FOV: 45 degrees, image size 2352x1568, retinal fundus photograph.
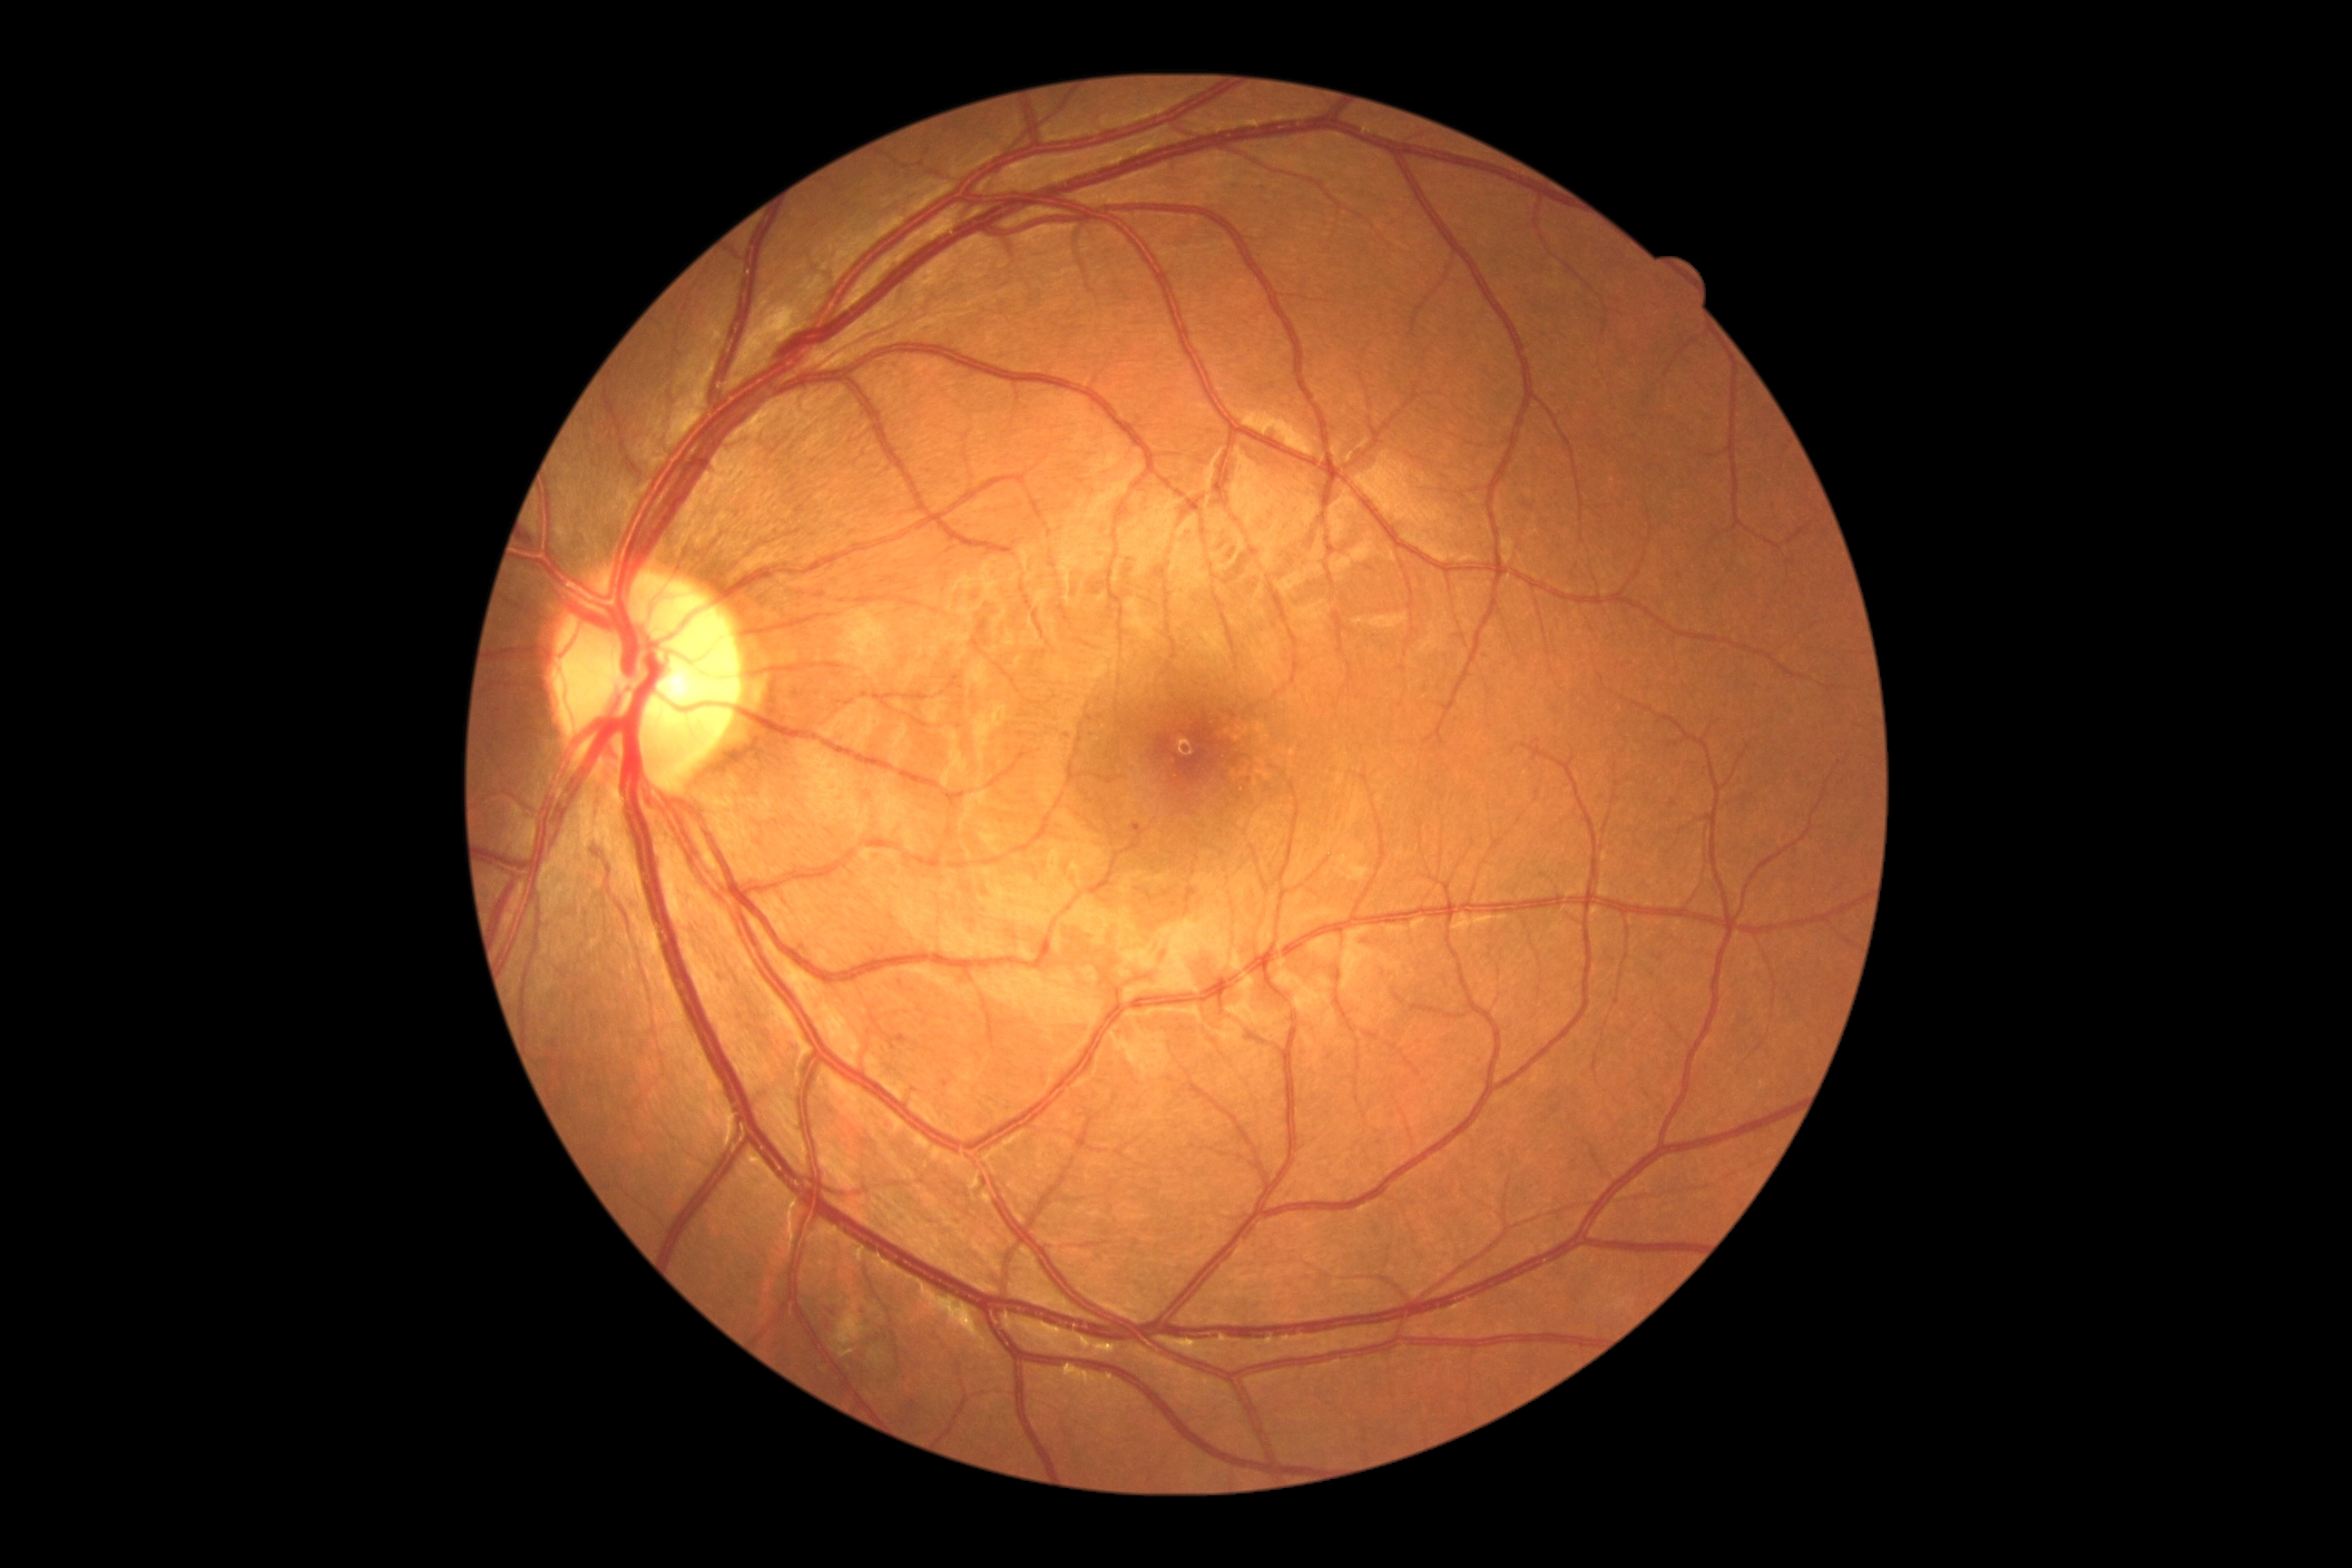
DR grade: 1 (mild NPDR) — presence of microaneurysms only.